2352x1568 — 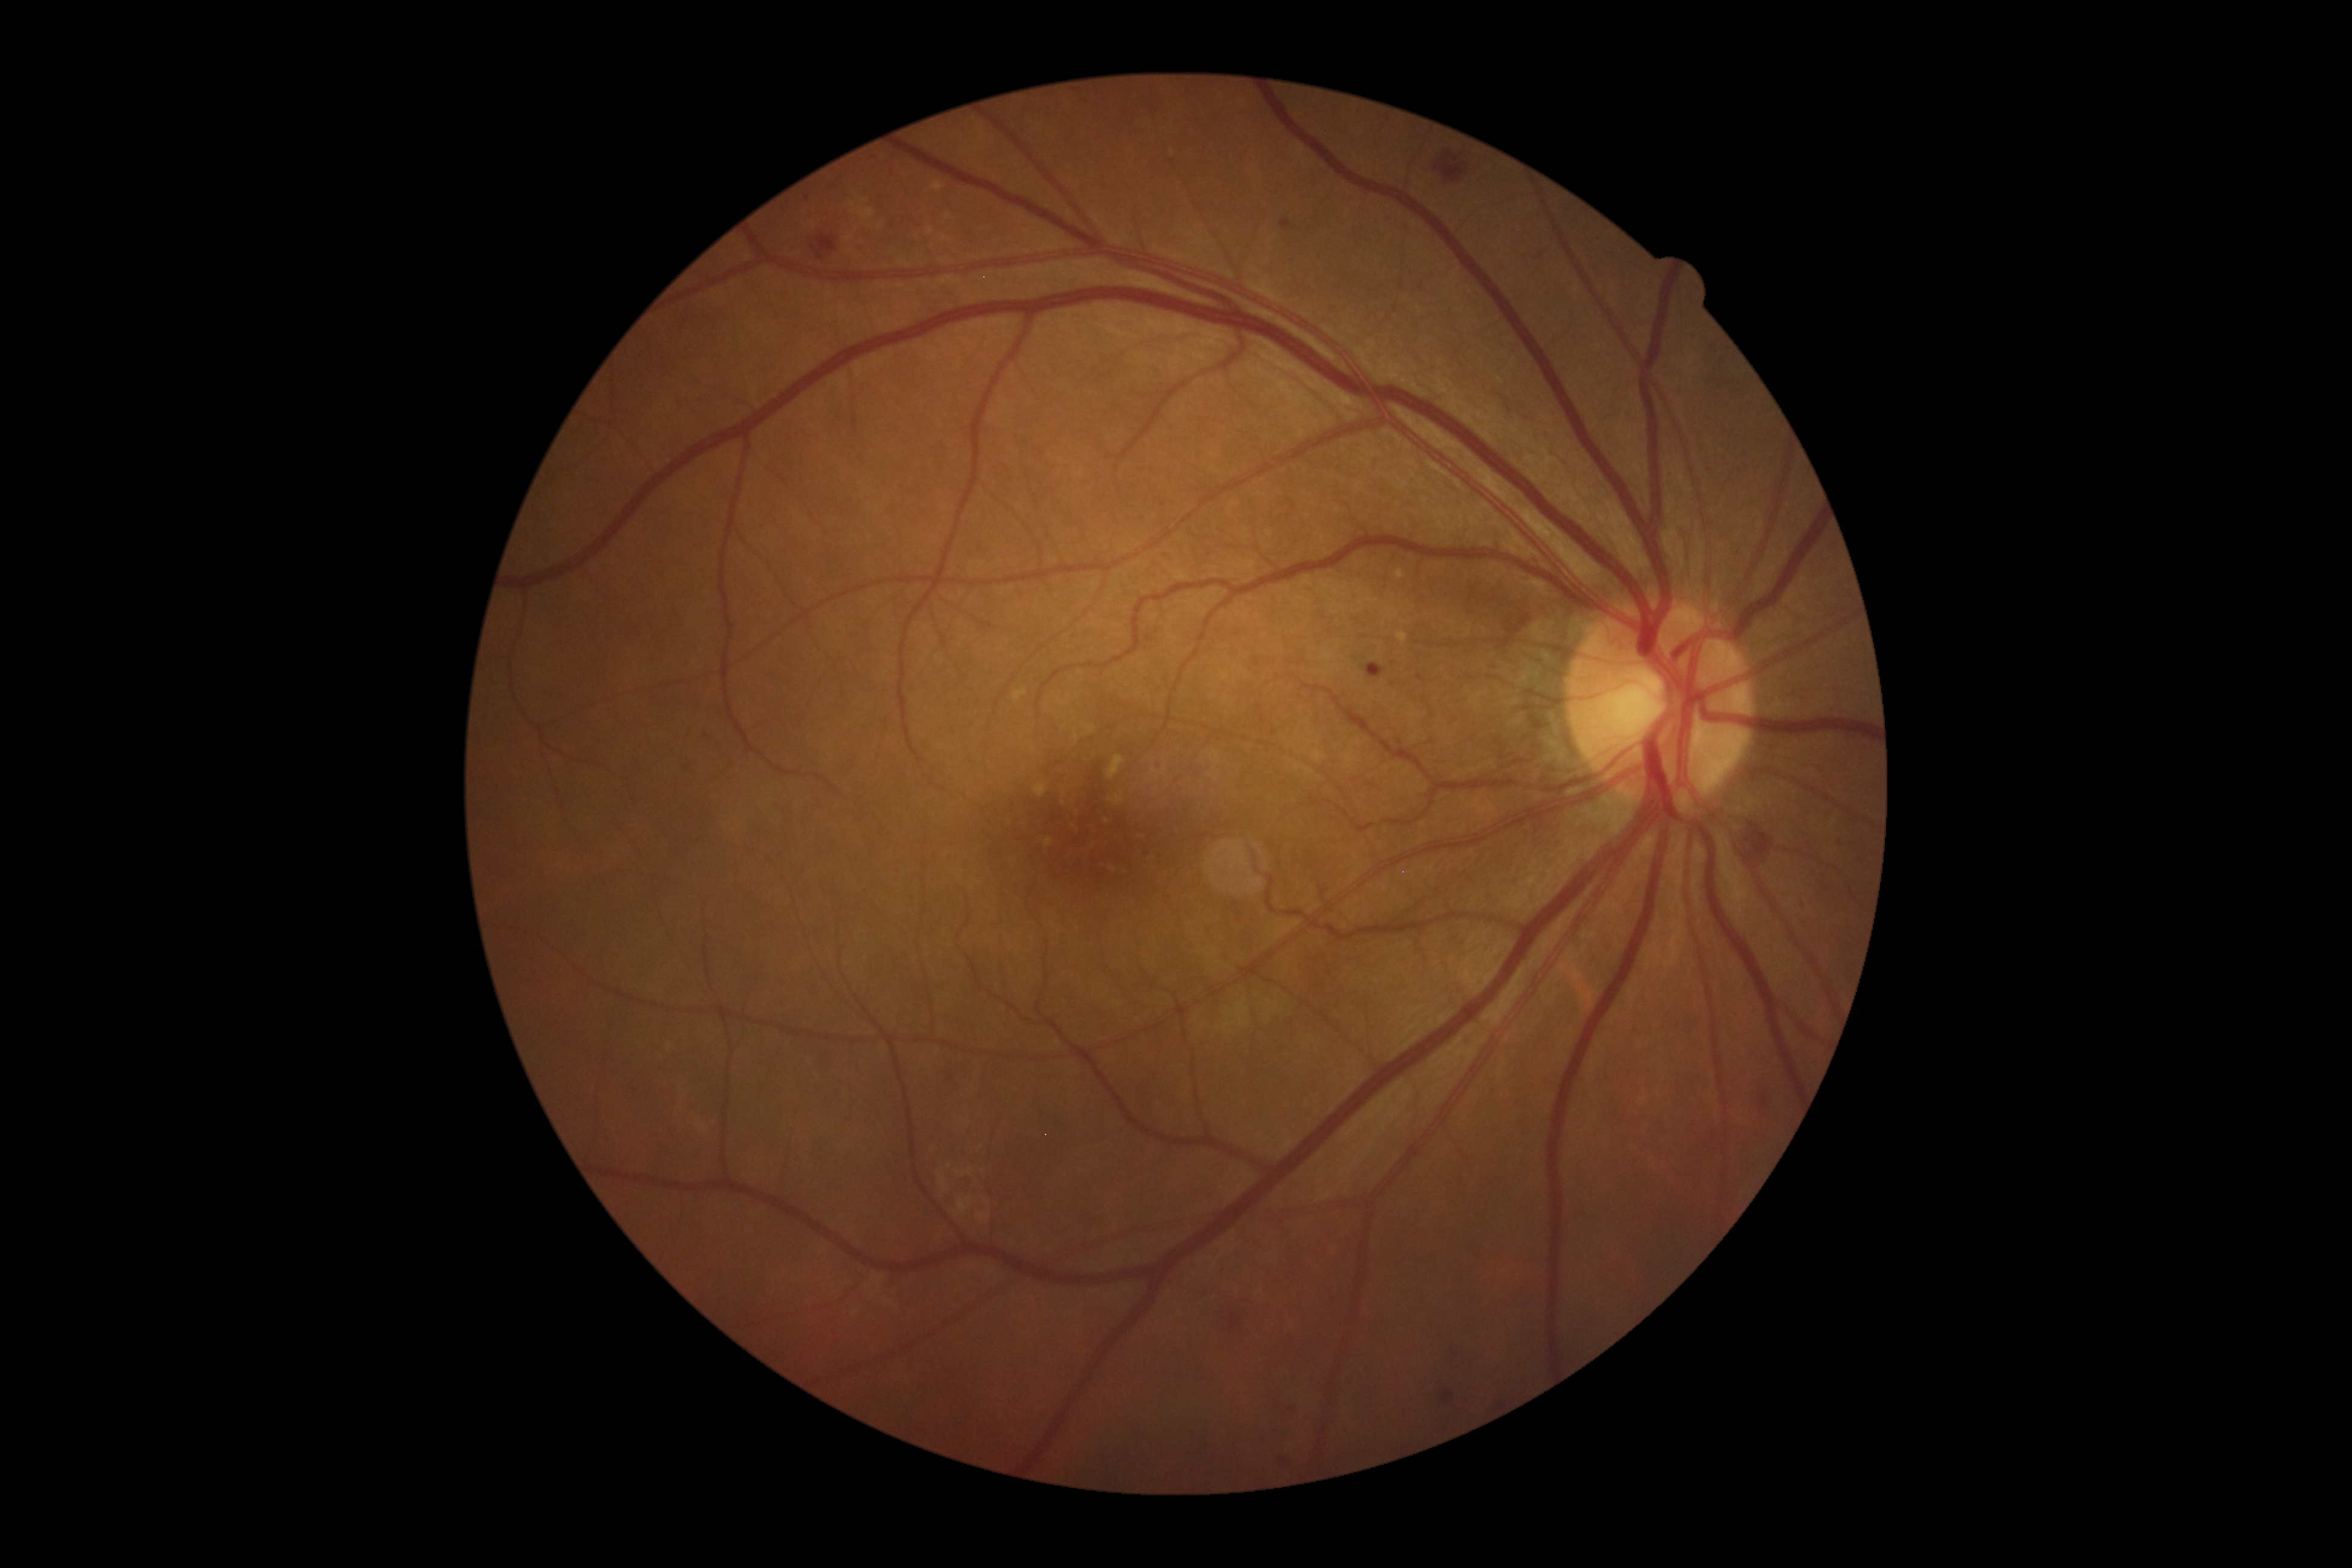

{"partial":true,"dr_grade":2,"lesions":{"he":[[812,233,837,261],[1231,1305,1243,1328],[1734,815,1777,872],[1434,149,1467,183]],"se":null,"ma":[[1156,760,1162,771],[1760,1094,1768,1110],[1279,220,1294,230],[1278,1451,1289,1460],[1448,1341,1462,1358],[1287,1400,1300,1408],[1365,662,1386,678],[1442,1388,1454,1403]],"ma_small":[[1147,853],[687,768],[1500,1404],[807,199]],"ex":null}}